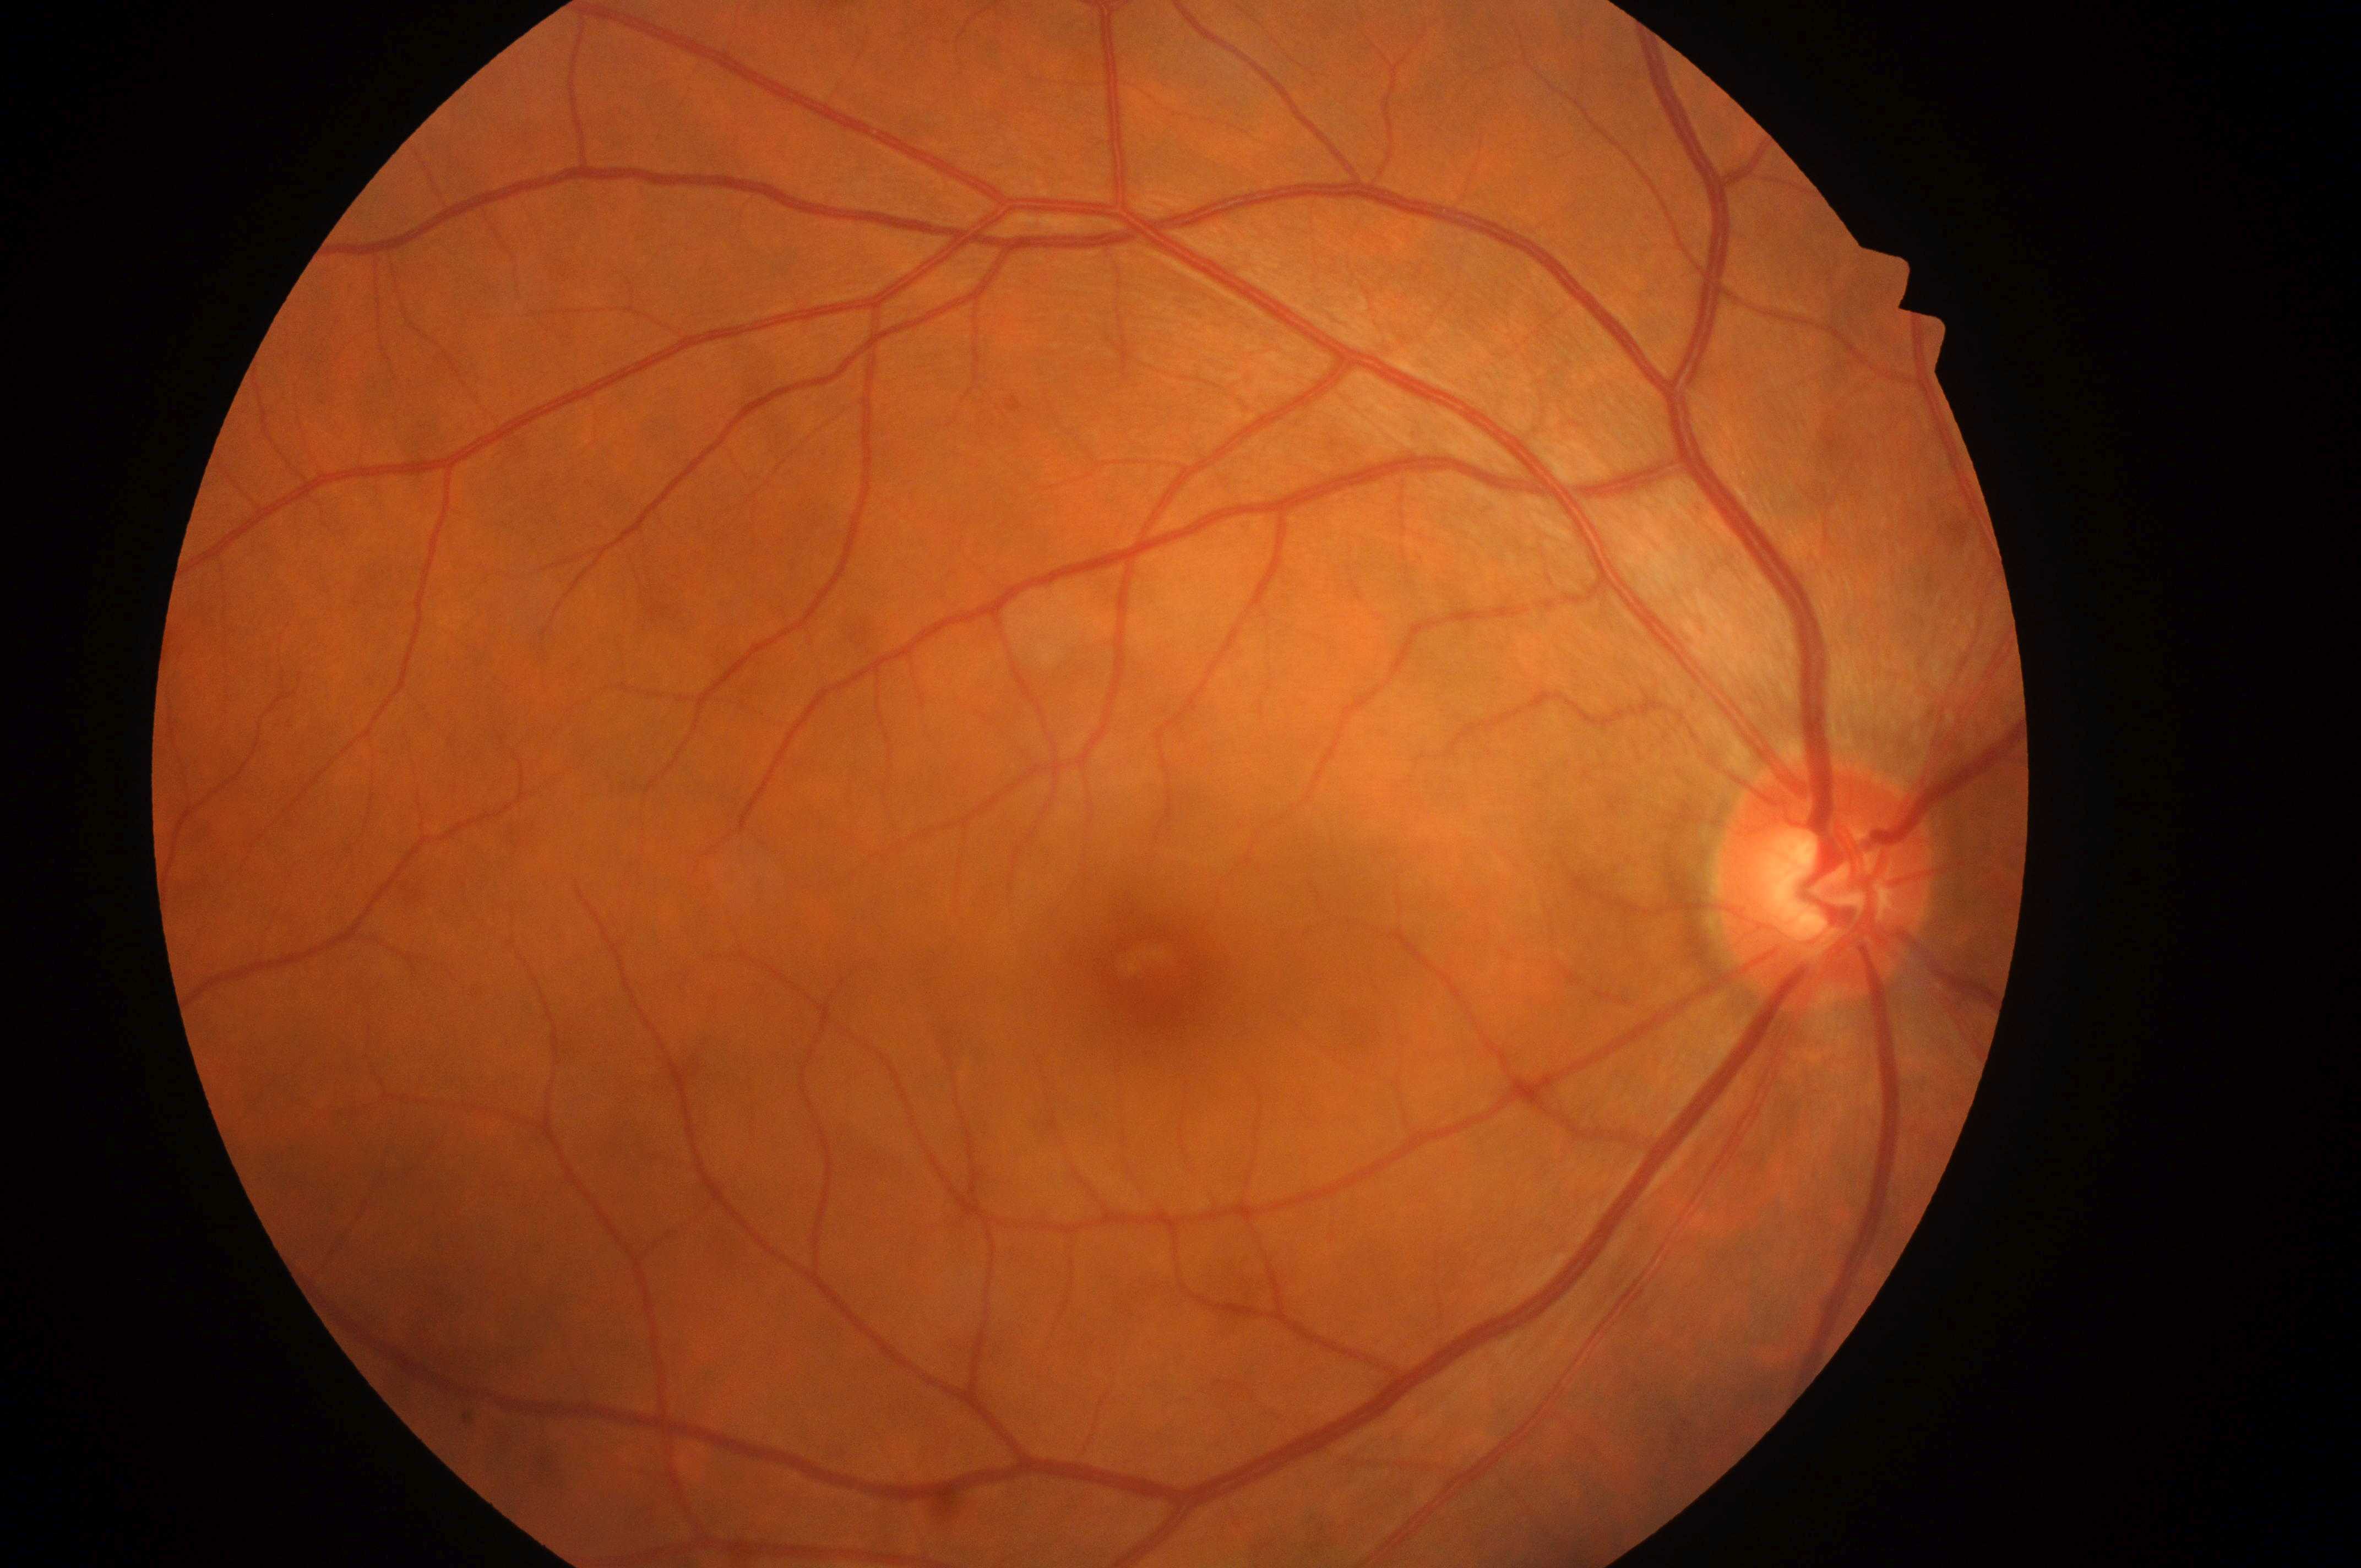
* DR severity — no apparent retinopathy (grade 0)
* eye — OD
* DME grade — no risk (0)
* macular center — [1159, 981]
* optic nerve head — [1824, 890]